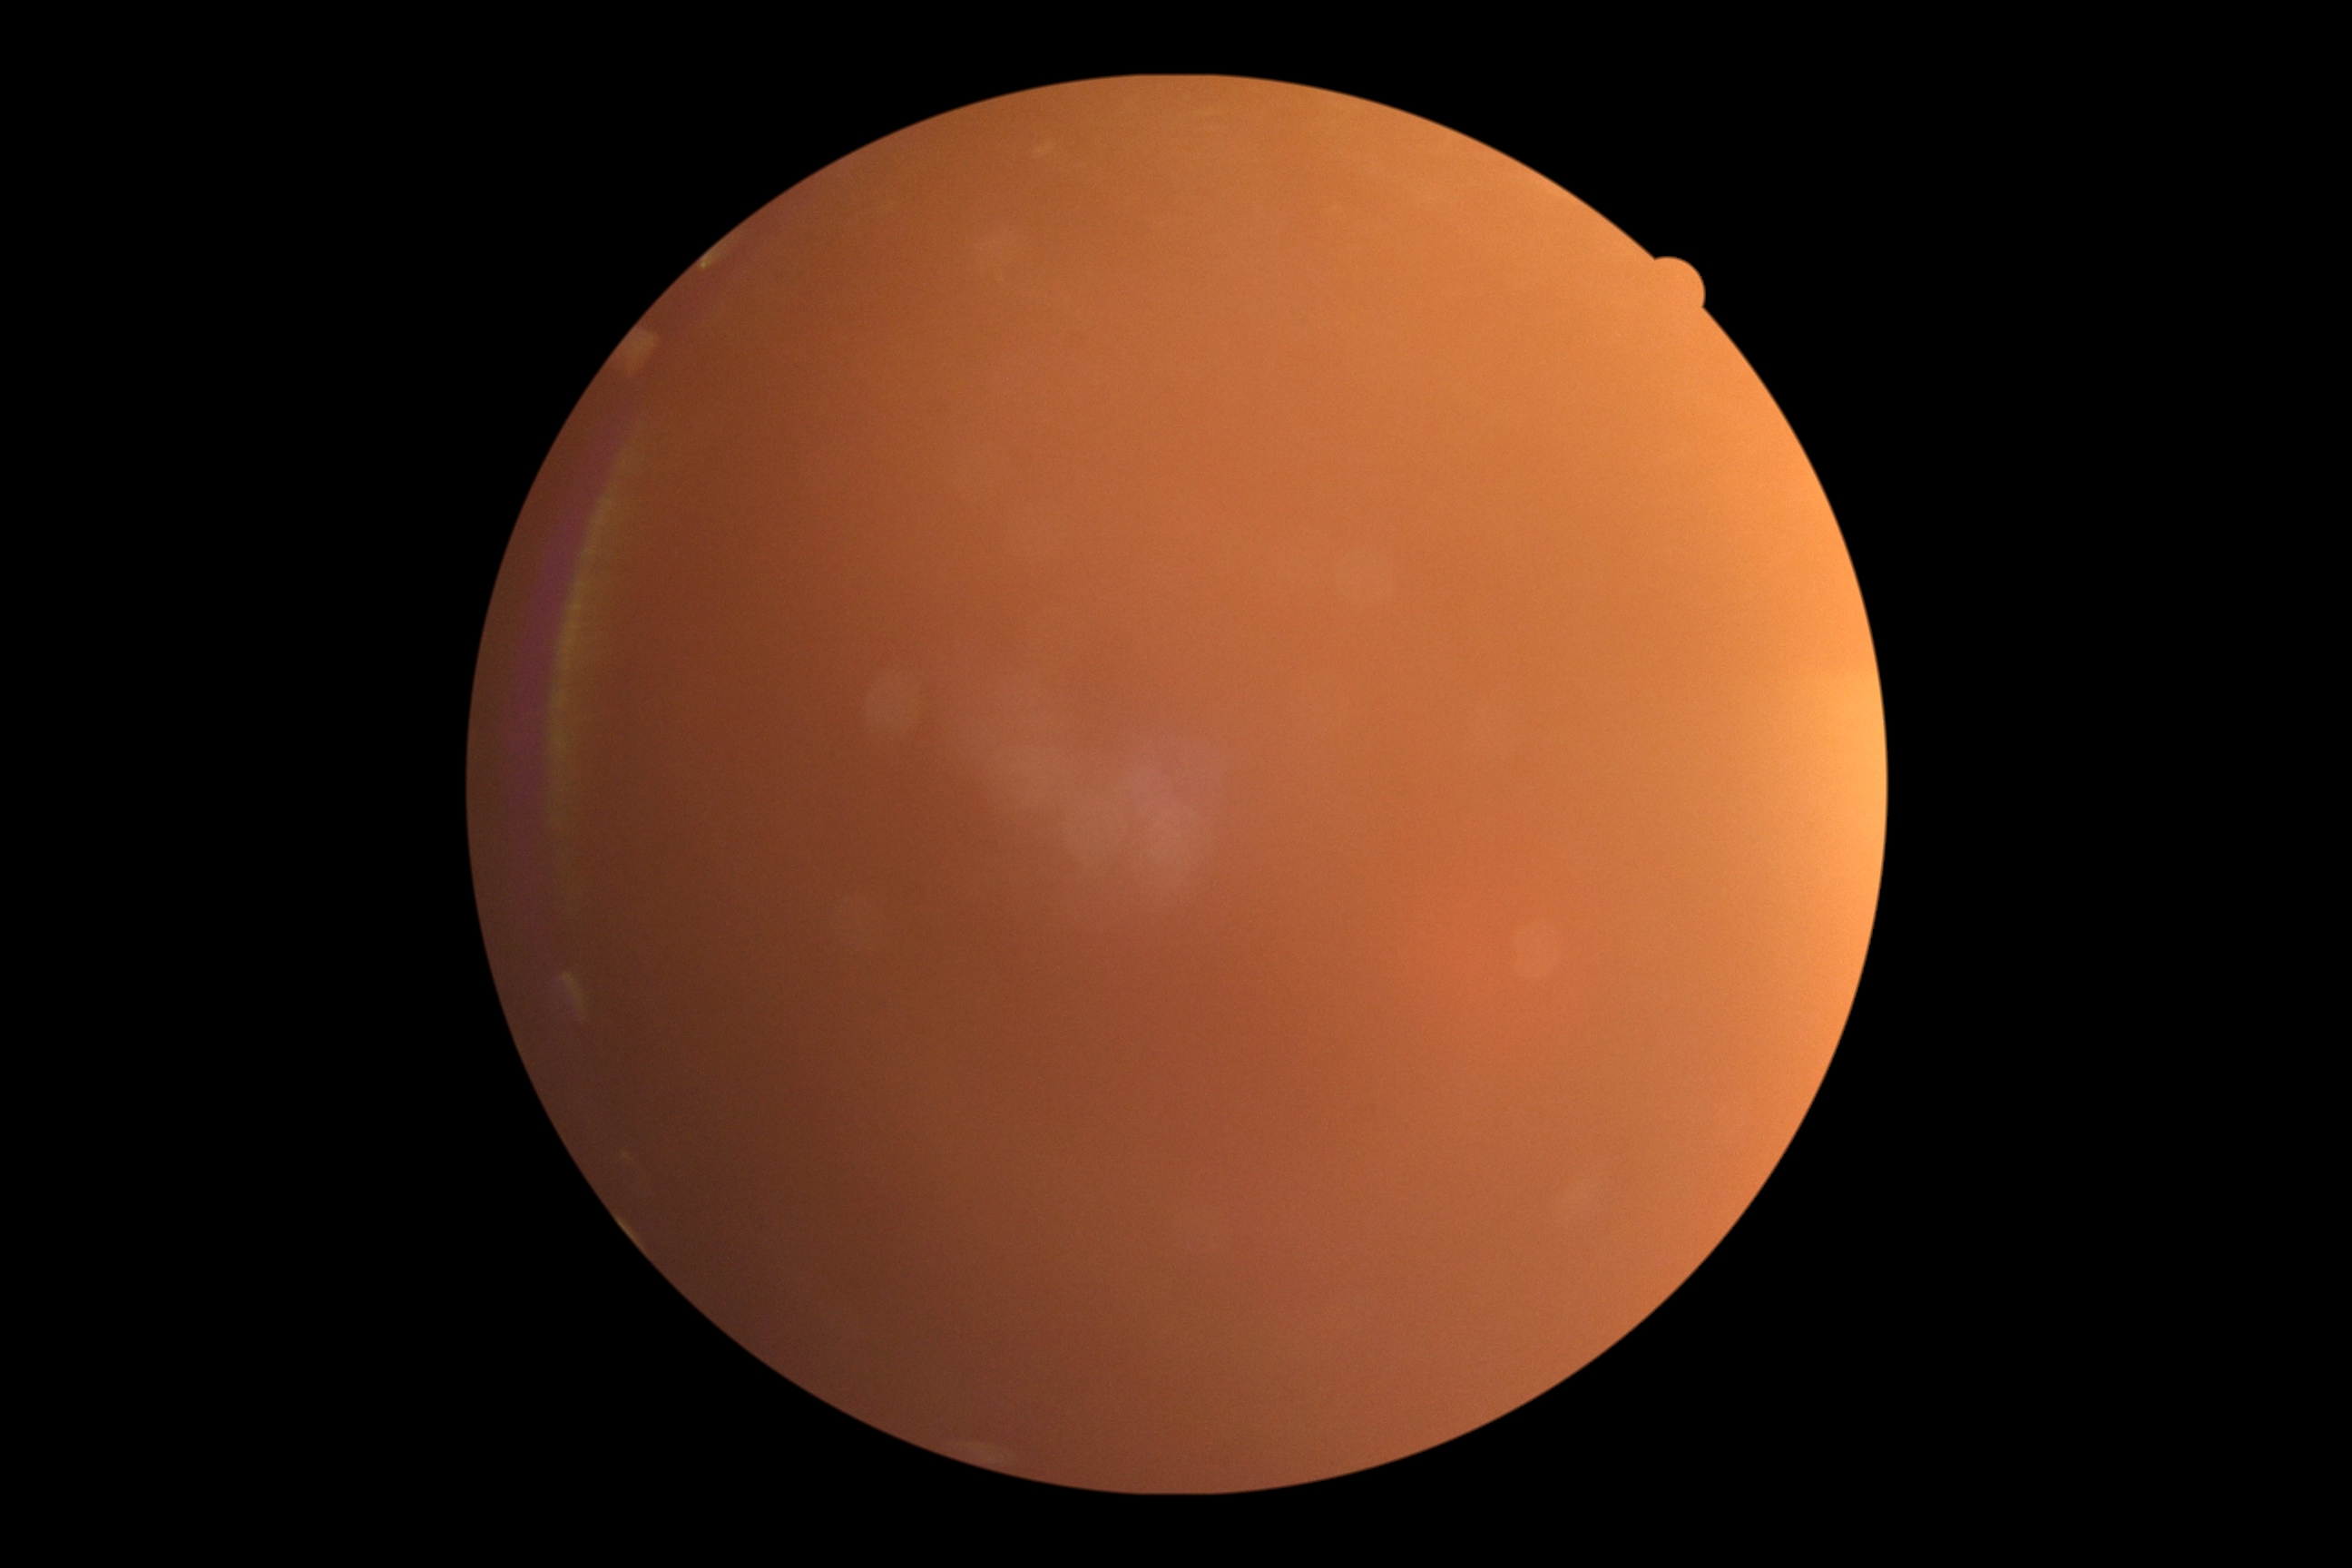 image quality = insufficient, diabetic retinopathy (DR) = ungradable due to poor image quality.